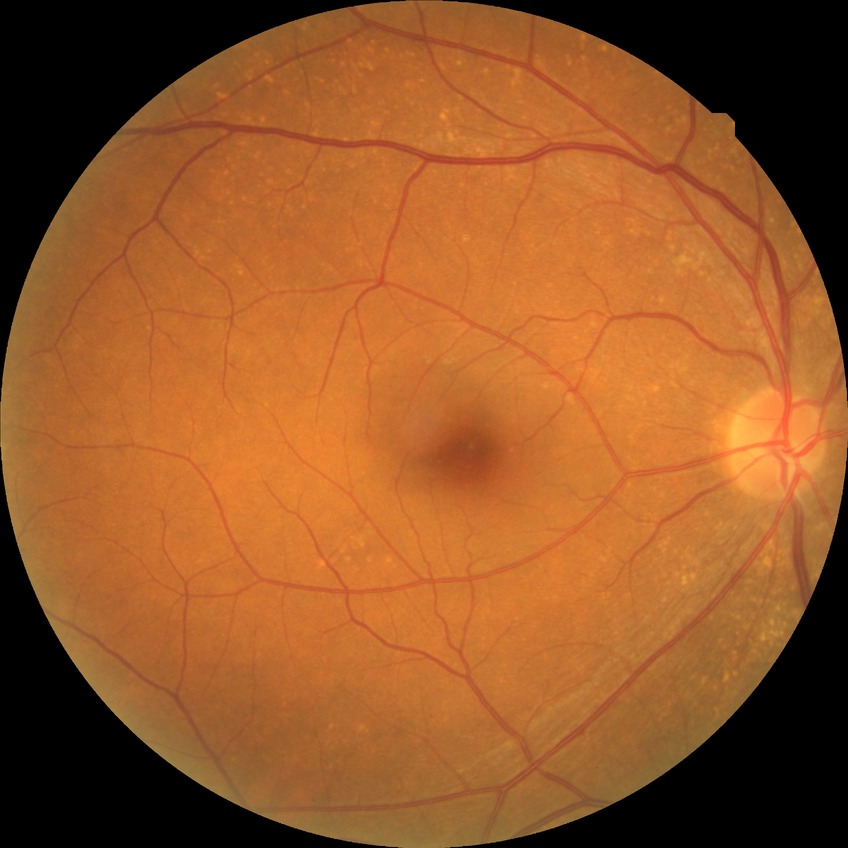 No diabetic retinal disease findings.
DR grade: NDR.